848 x 848 pixels.
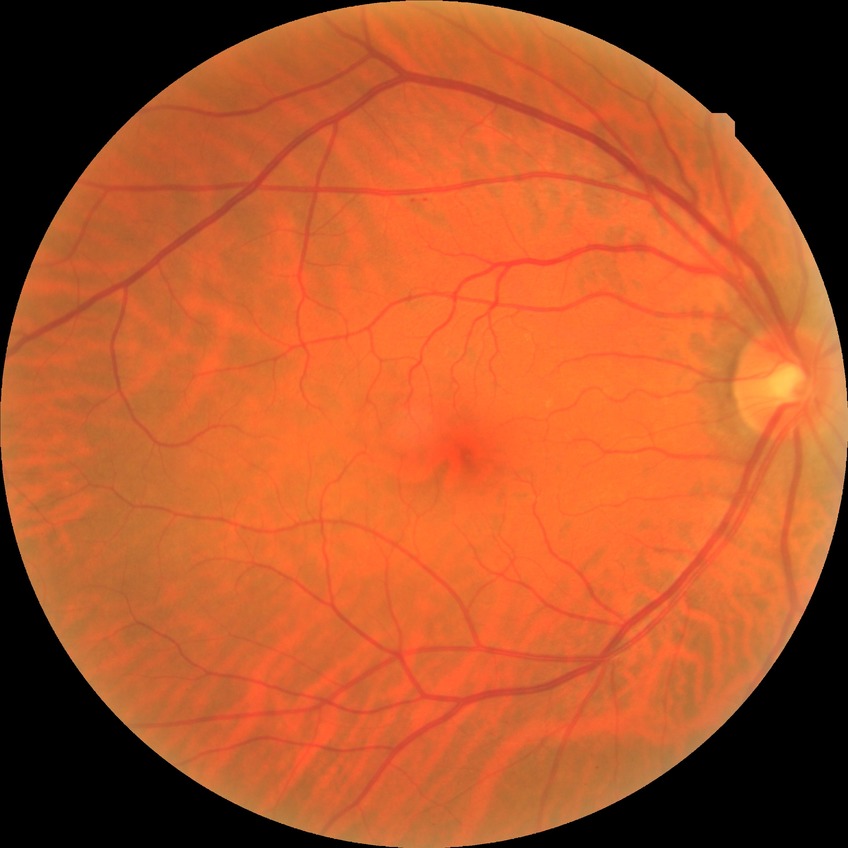
Findings:
• DR severity: NDR